Acquired on the Phoenix ICON · 1240x1240 · wide-field fundus image from infant ROP screening.
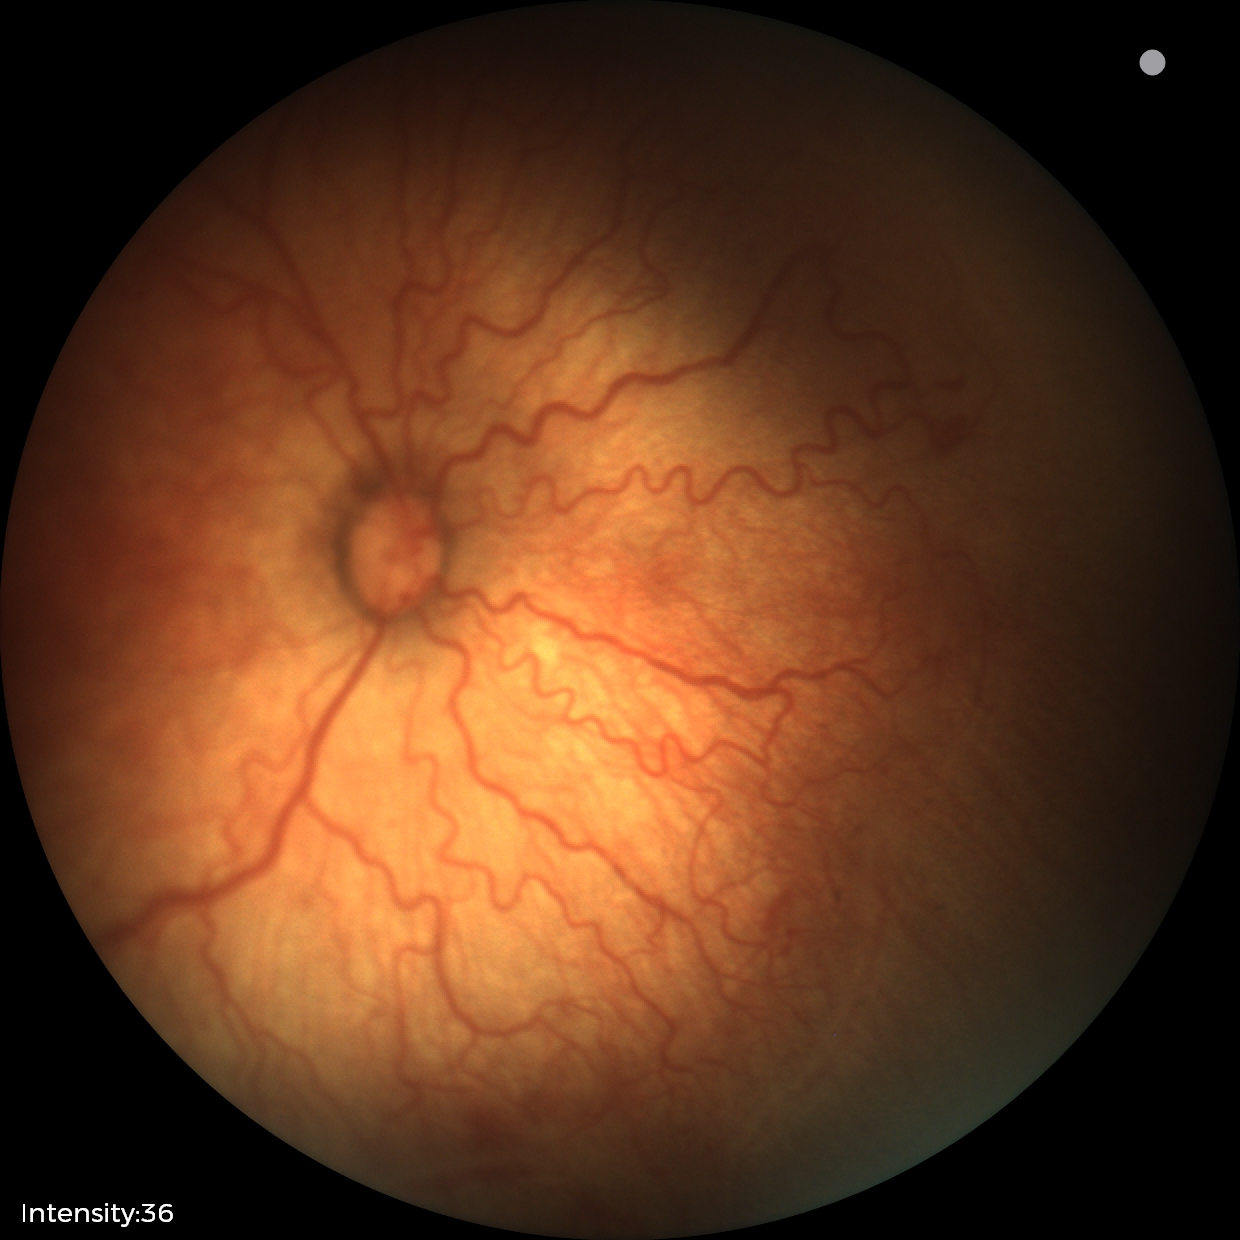
Plus form: present | screening diagnosis: retinopathy of prematurity (ROP) stage 2.